Posterior pole photograph. FOV: 45 degrees:
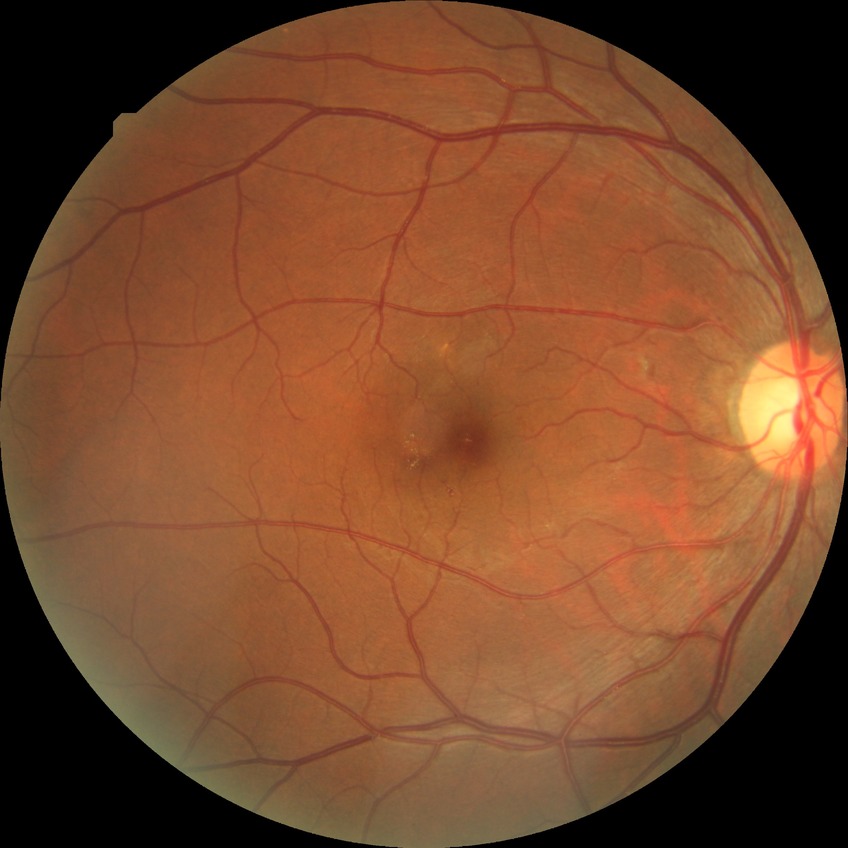

Disease class: non-proliferative diabetic retinopathy. Modified Davis classification: simple diabetic retinopathy.